45° FOV
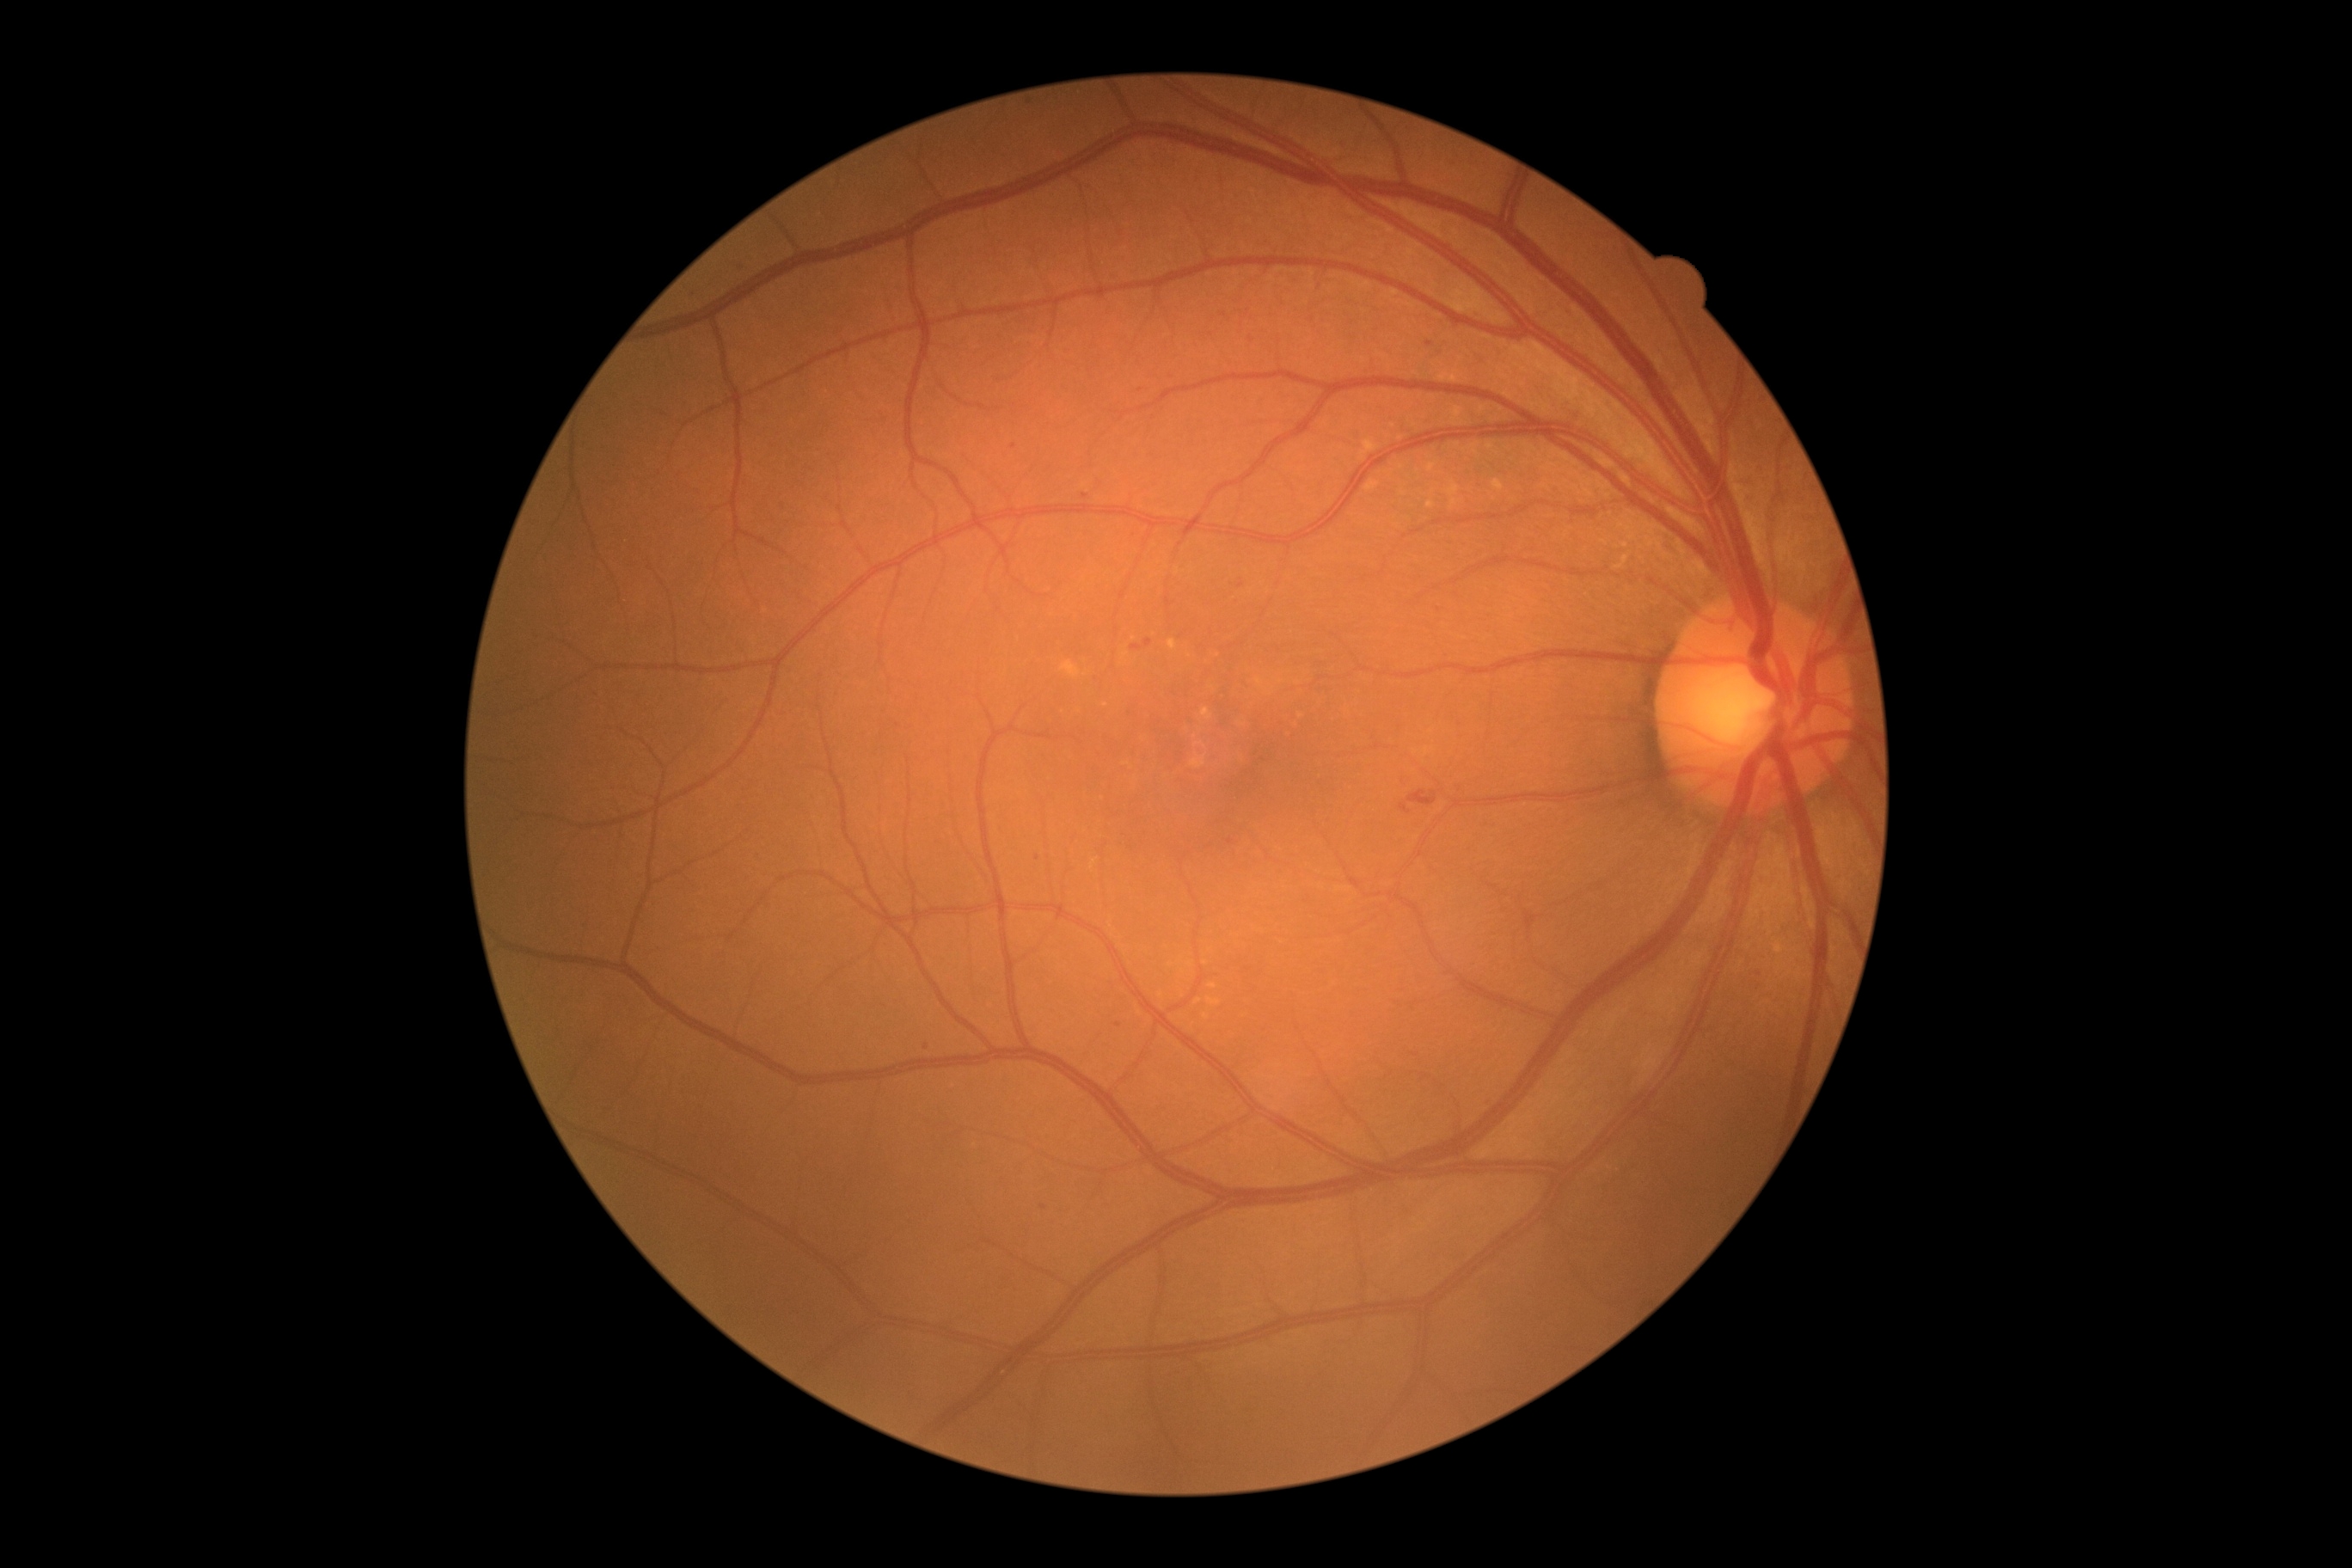 Diabetic retinopathy (DR) is moderate non-proliferative diabetic retinopathy (grade 2); non-proliferative diabetic retinopathy
A subset of detected lesions:
hard exudates (EXs): not present
microaneurysms (MAs) (more not shown): <box>1115,1024,1124,1029</box>; <box>1225,840,1237,847</box>; <box>1220,312,1228,319</box>; <box>1426,341,1435,348</box>; <box>1261,757,1270,763</box>; <box>1130,644,1142,651</box>; <box>1081,494,1089,501</box>
Small MAs near x=1251, y=339; x=898, y=726; x=1044, y=1208; x=1038, y=858; x=1014, y=447; x=926, y=1047; x=1141, y=391; x=1759, y=974
soft exudates (SEs): not present
hemorrhages (HEs): <box>1399,790,1445,816</box>